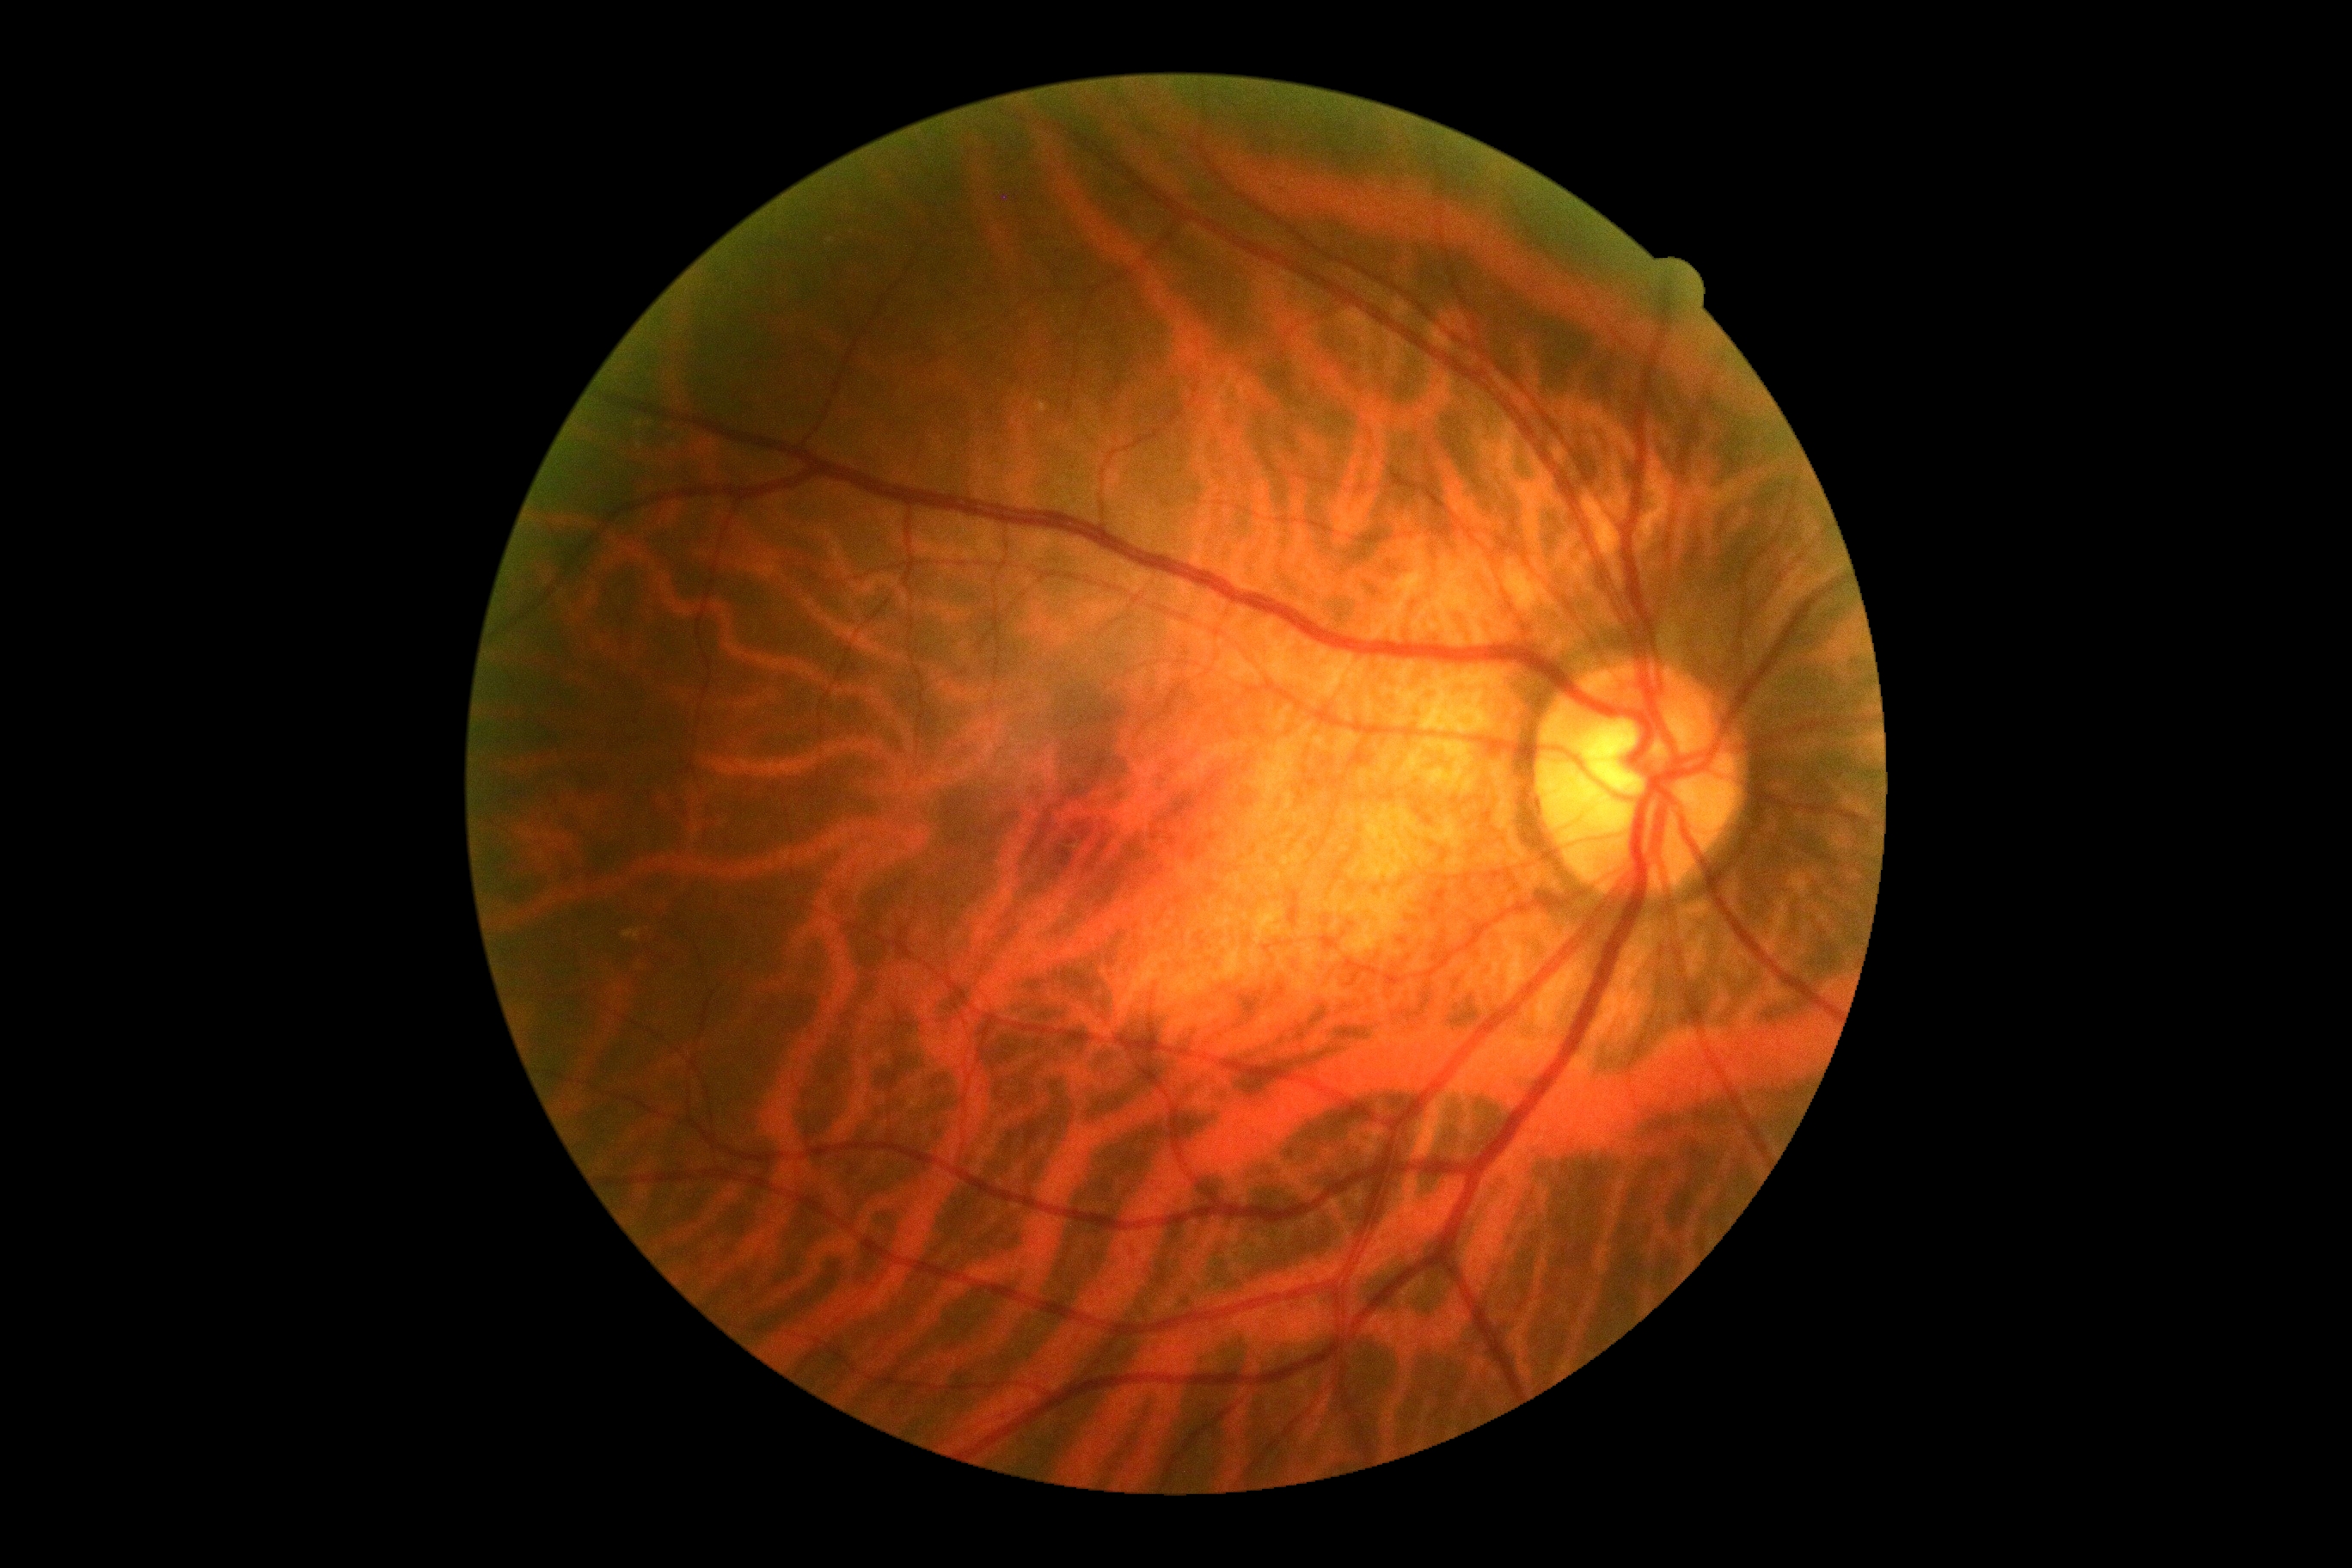

DR severity is 0/4.